UWF retinal mosaic.
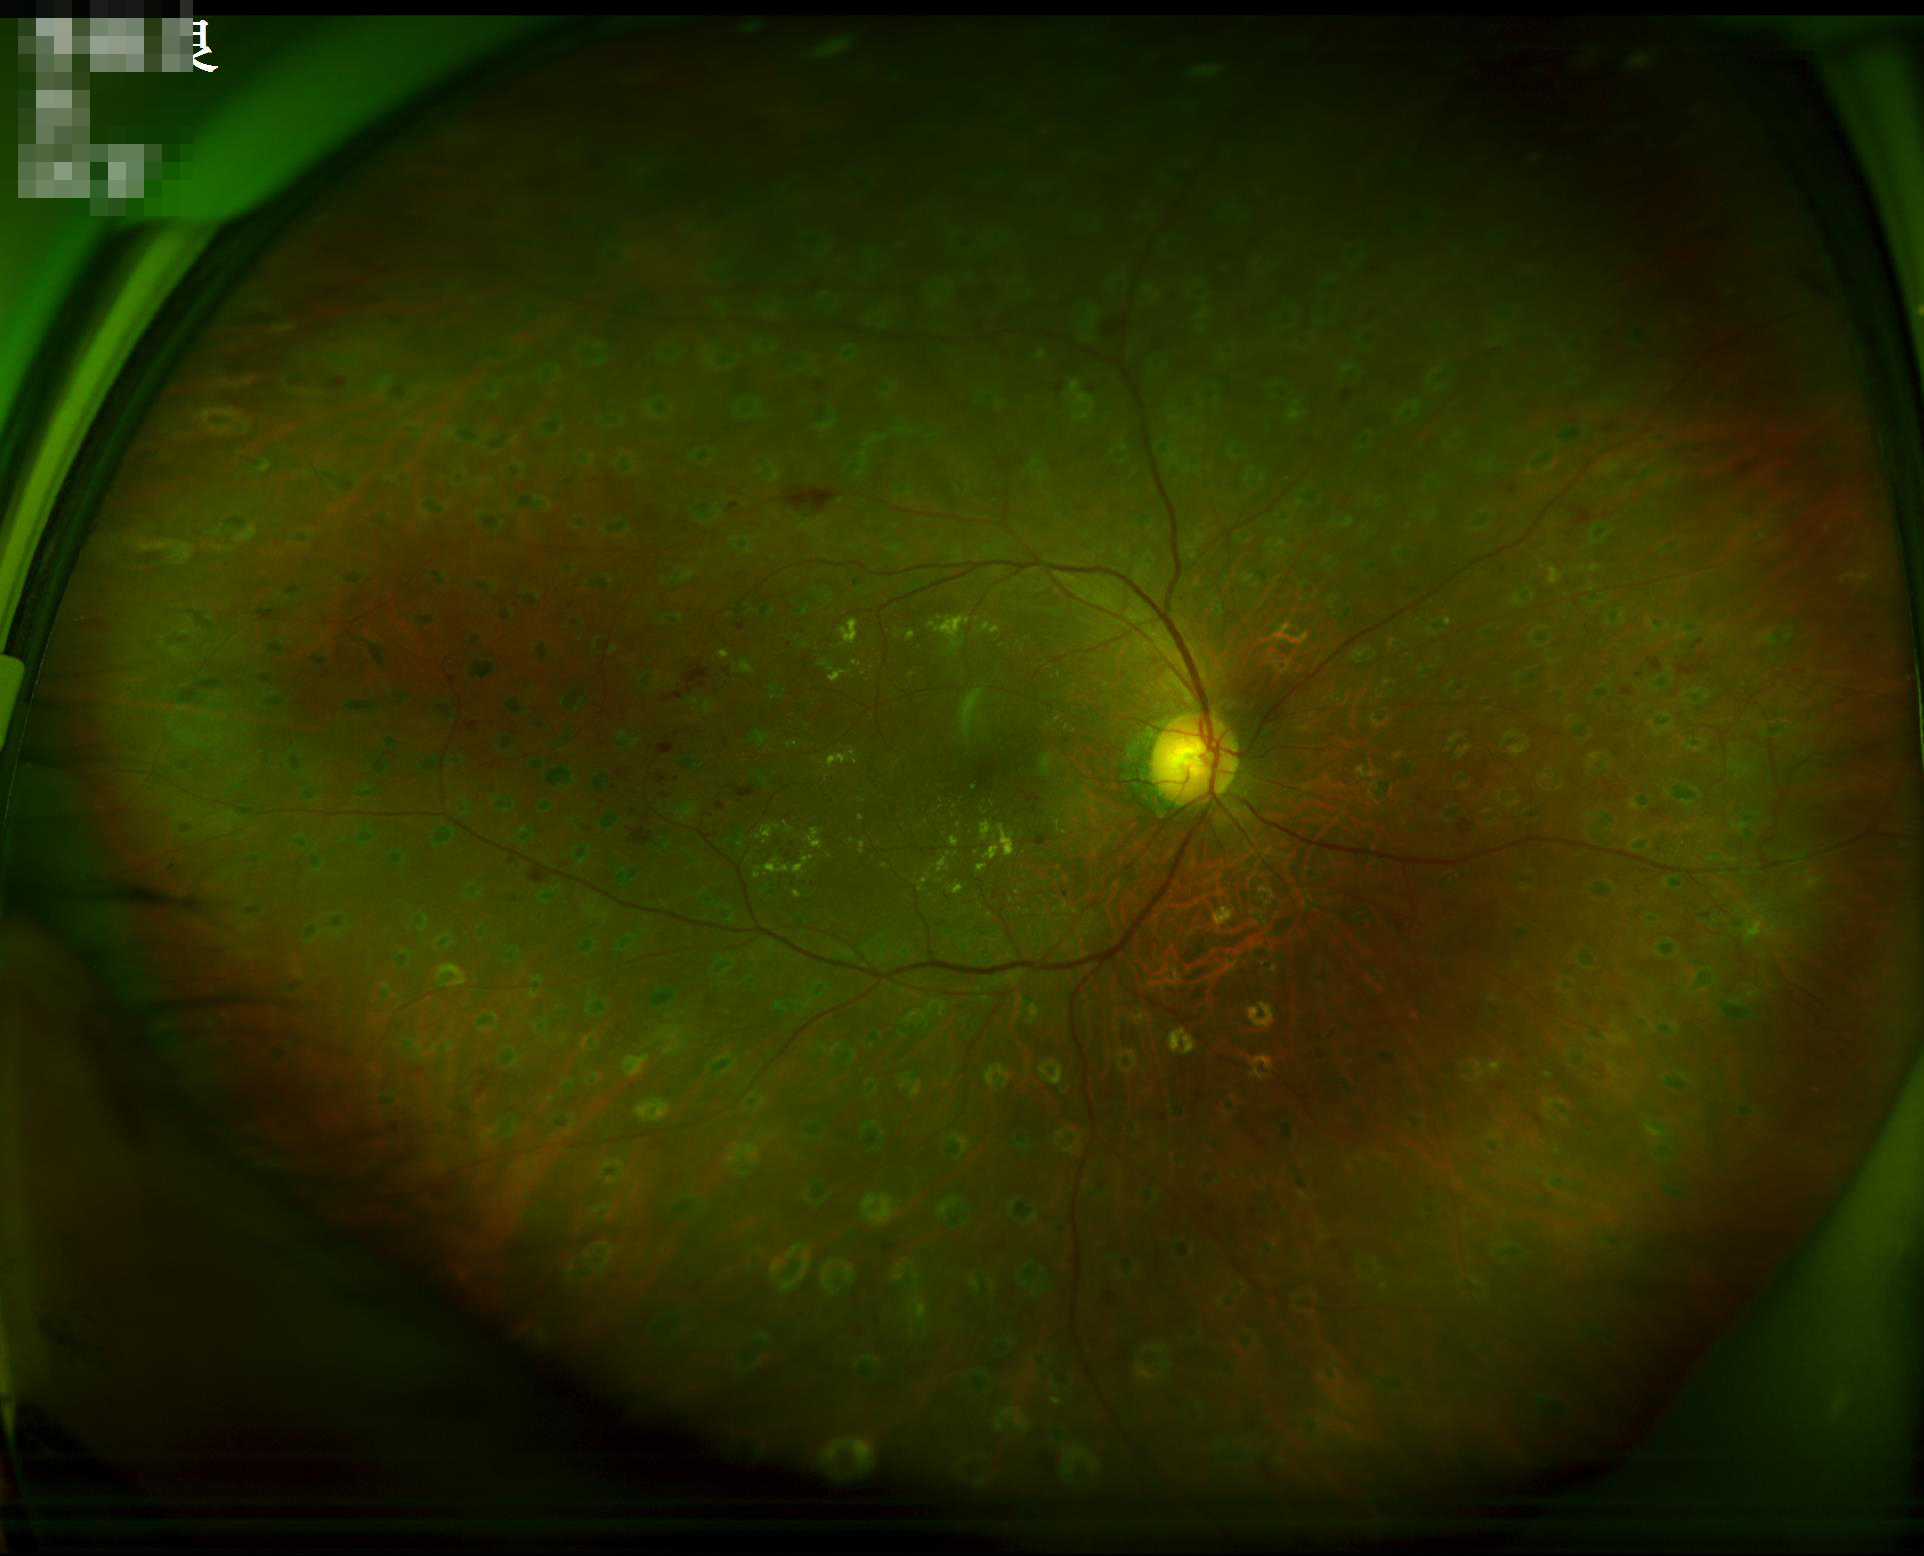

Overall quality is good and the image is gradable. Vessels and details are readily distinguishable.